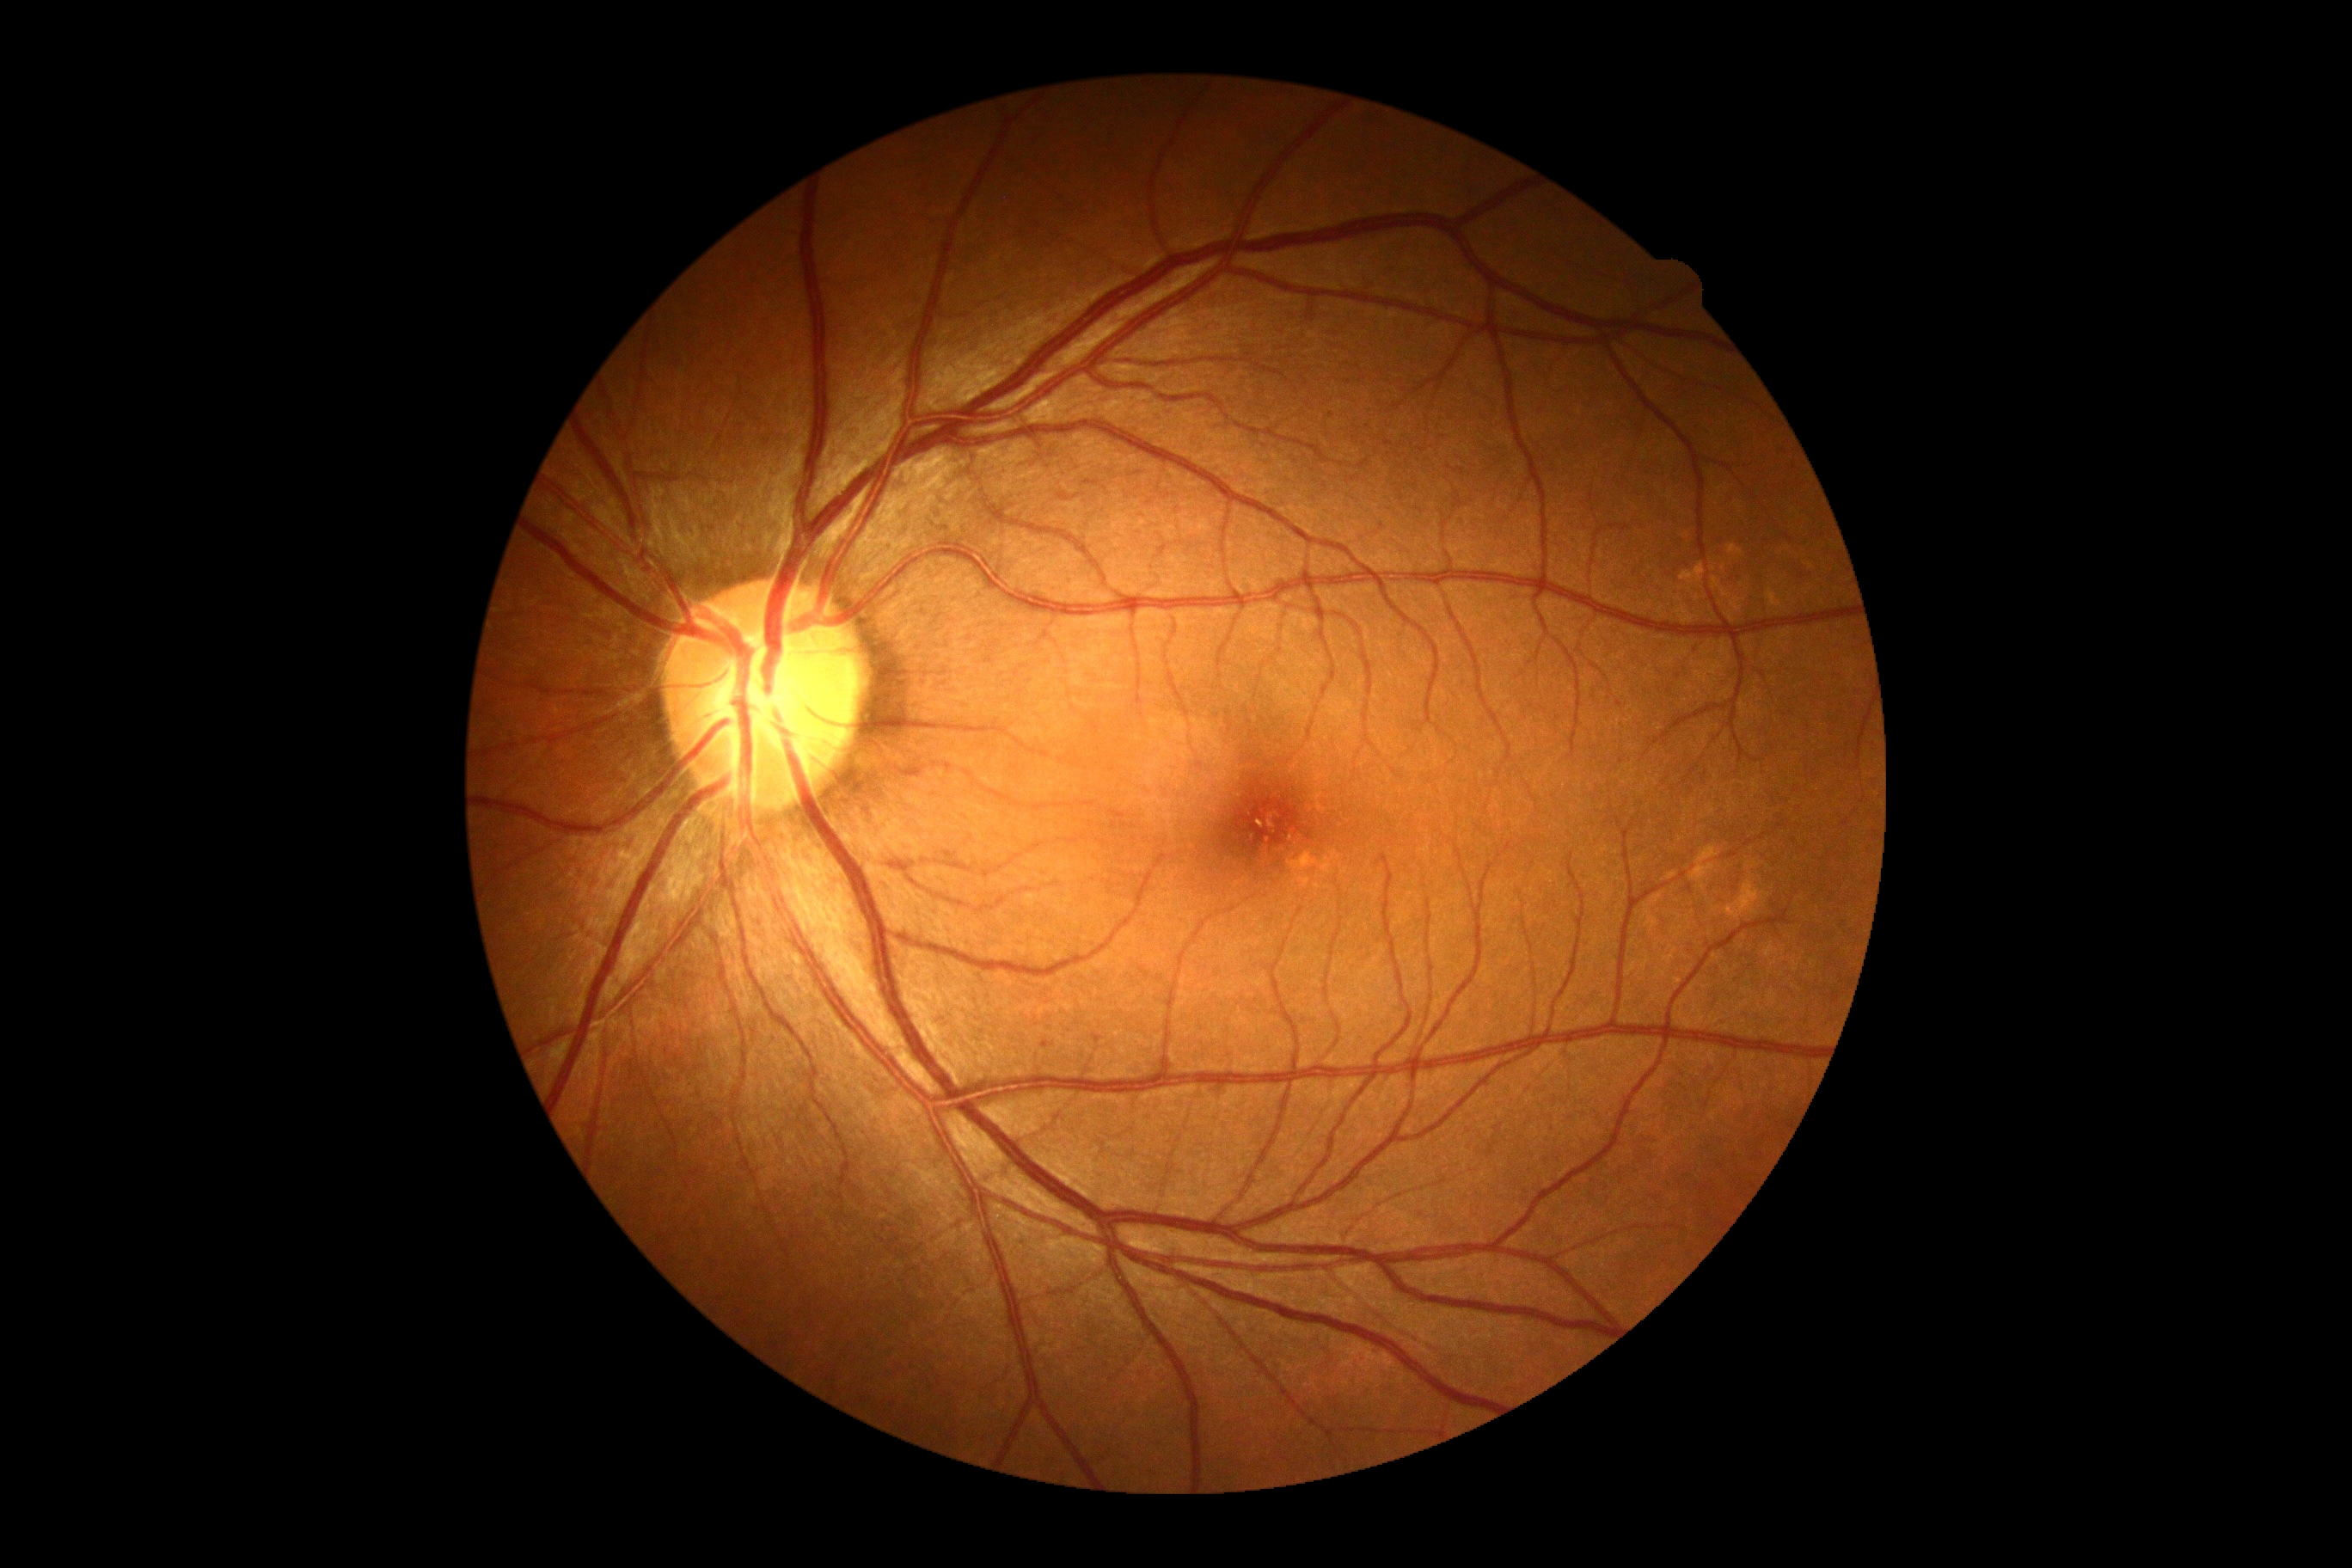 DR stage is grade 0 (no apparent retinopathy).